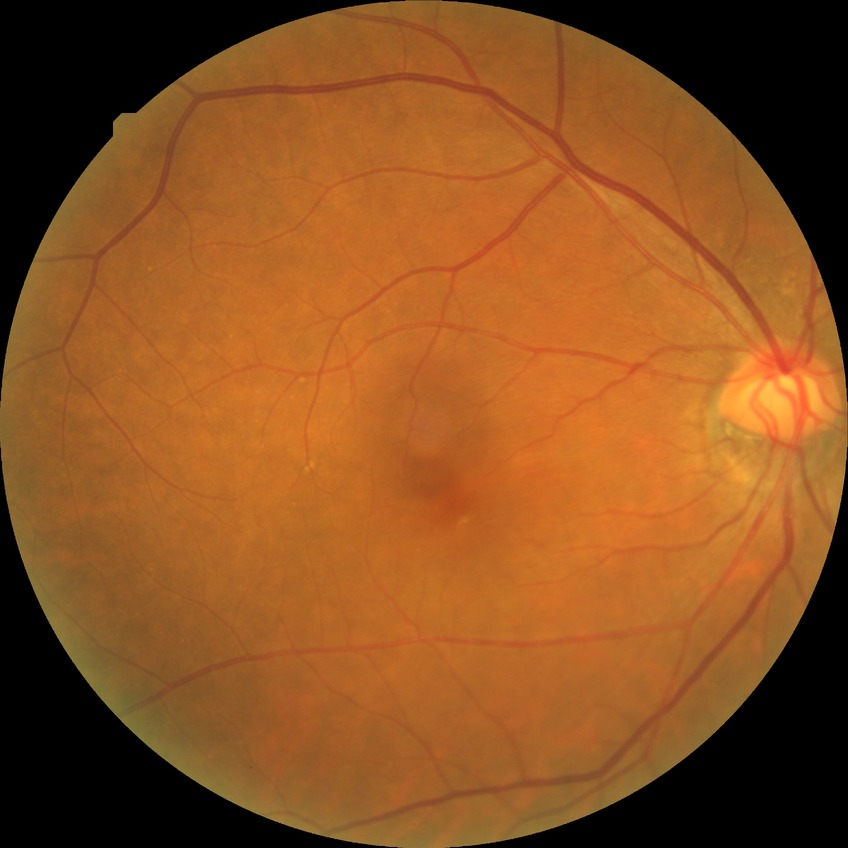 diabetic retinopathy (DR): NDR (no diabetic retinopathy).